Acquired on the Natus RetCam Envision. Pediatric wide-field fundus photograph. Image size 1440x1080:
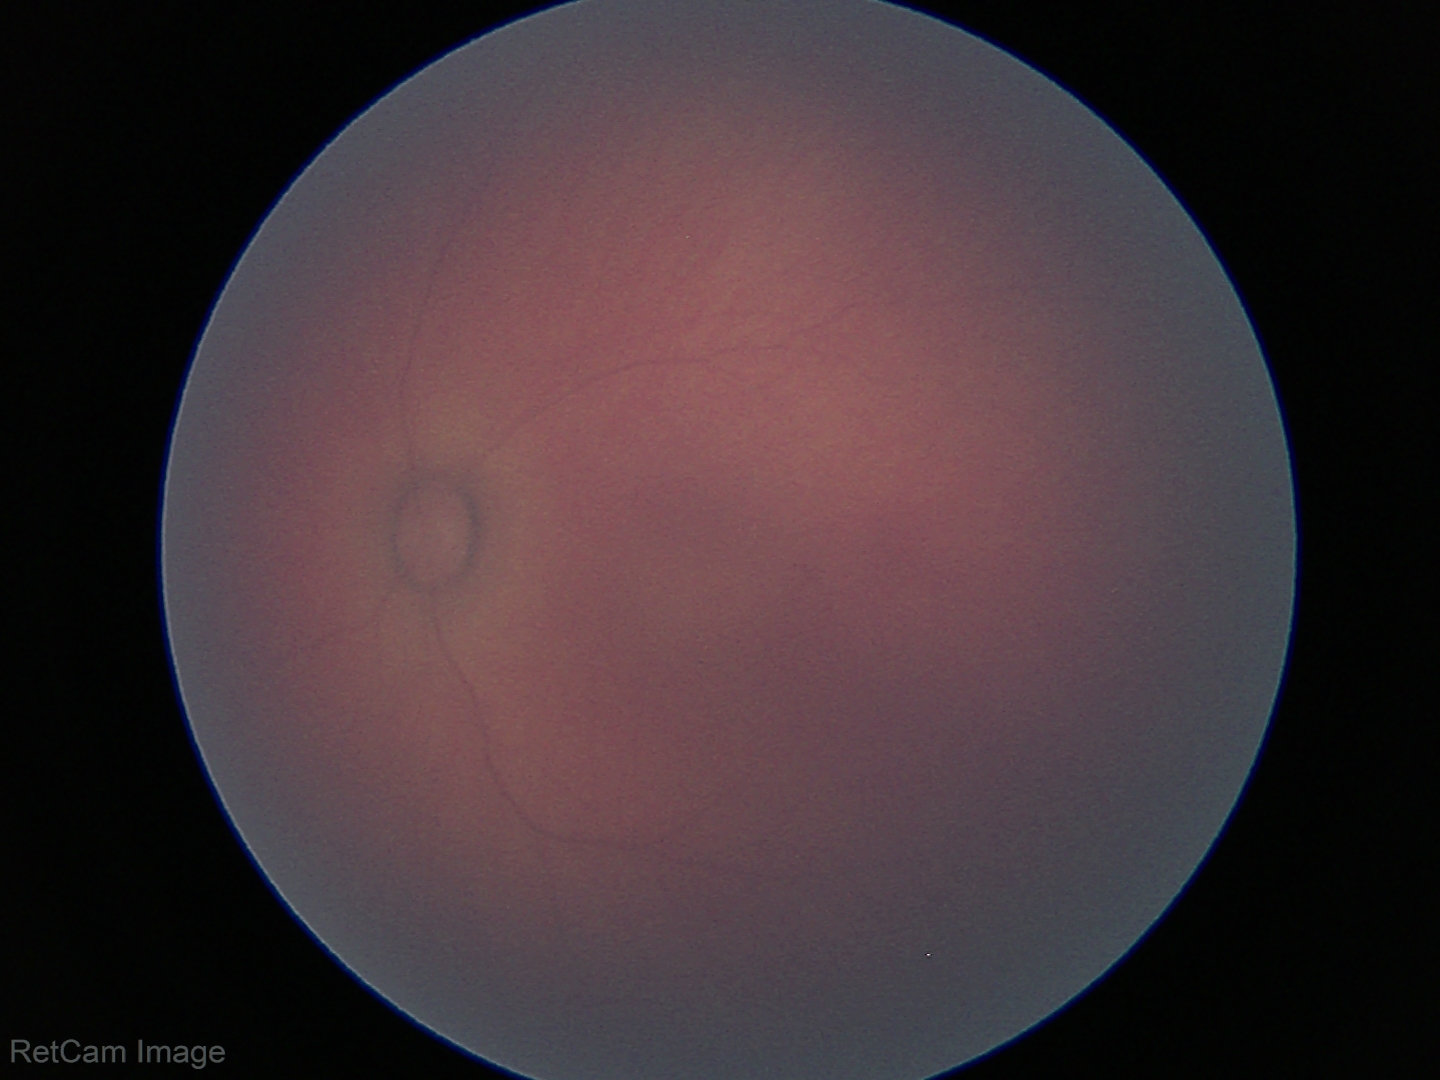 No retinal pathology identified on screening.